Color fundus image. 45° FOV.
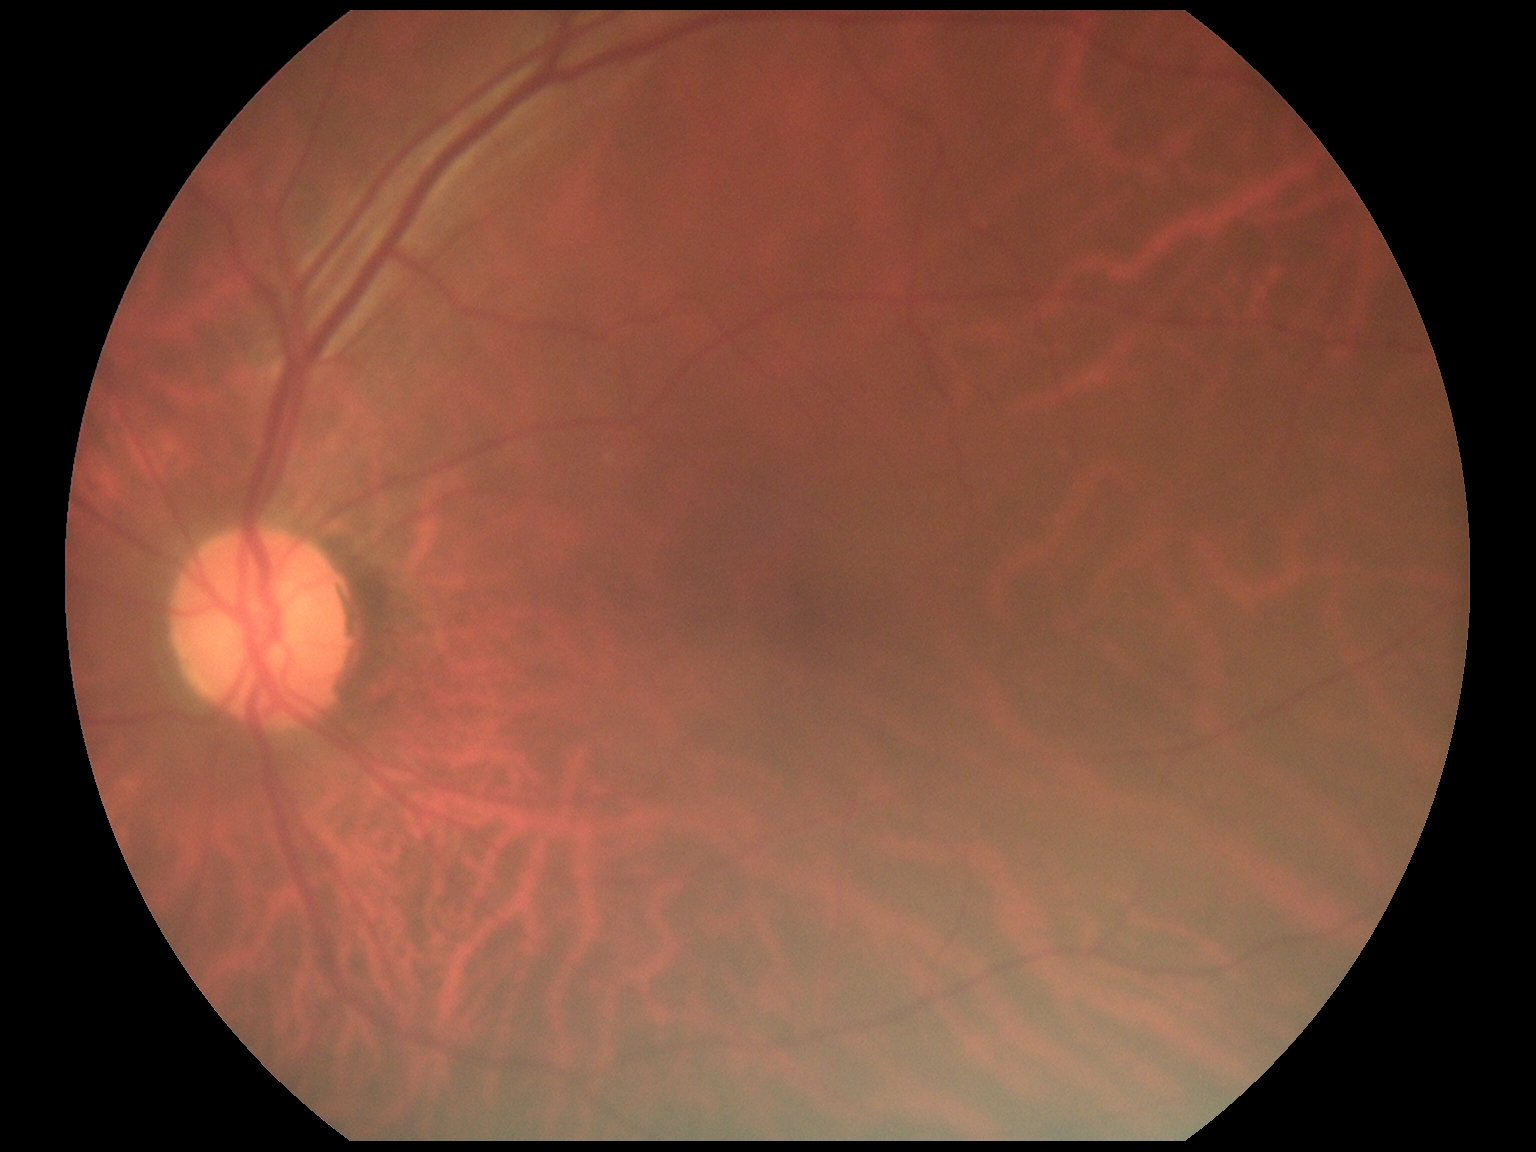

DR impression=no apparent DR; DR=0/4.